Color fundus photograph; 2184 by 1690 pixels — 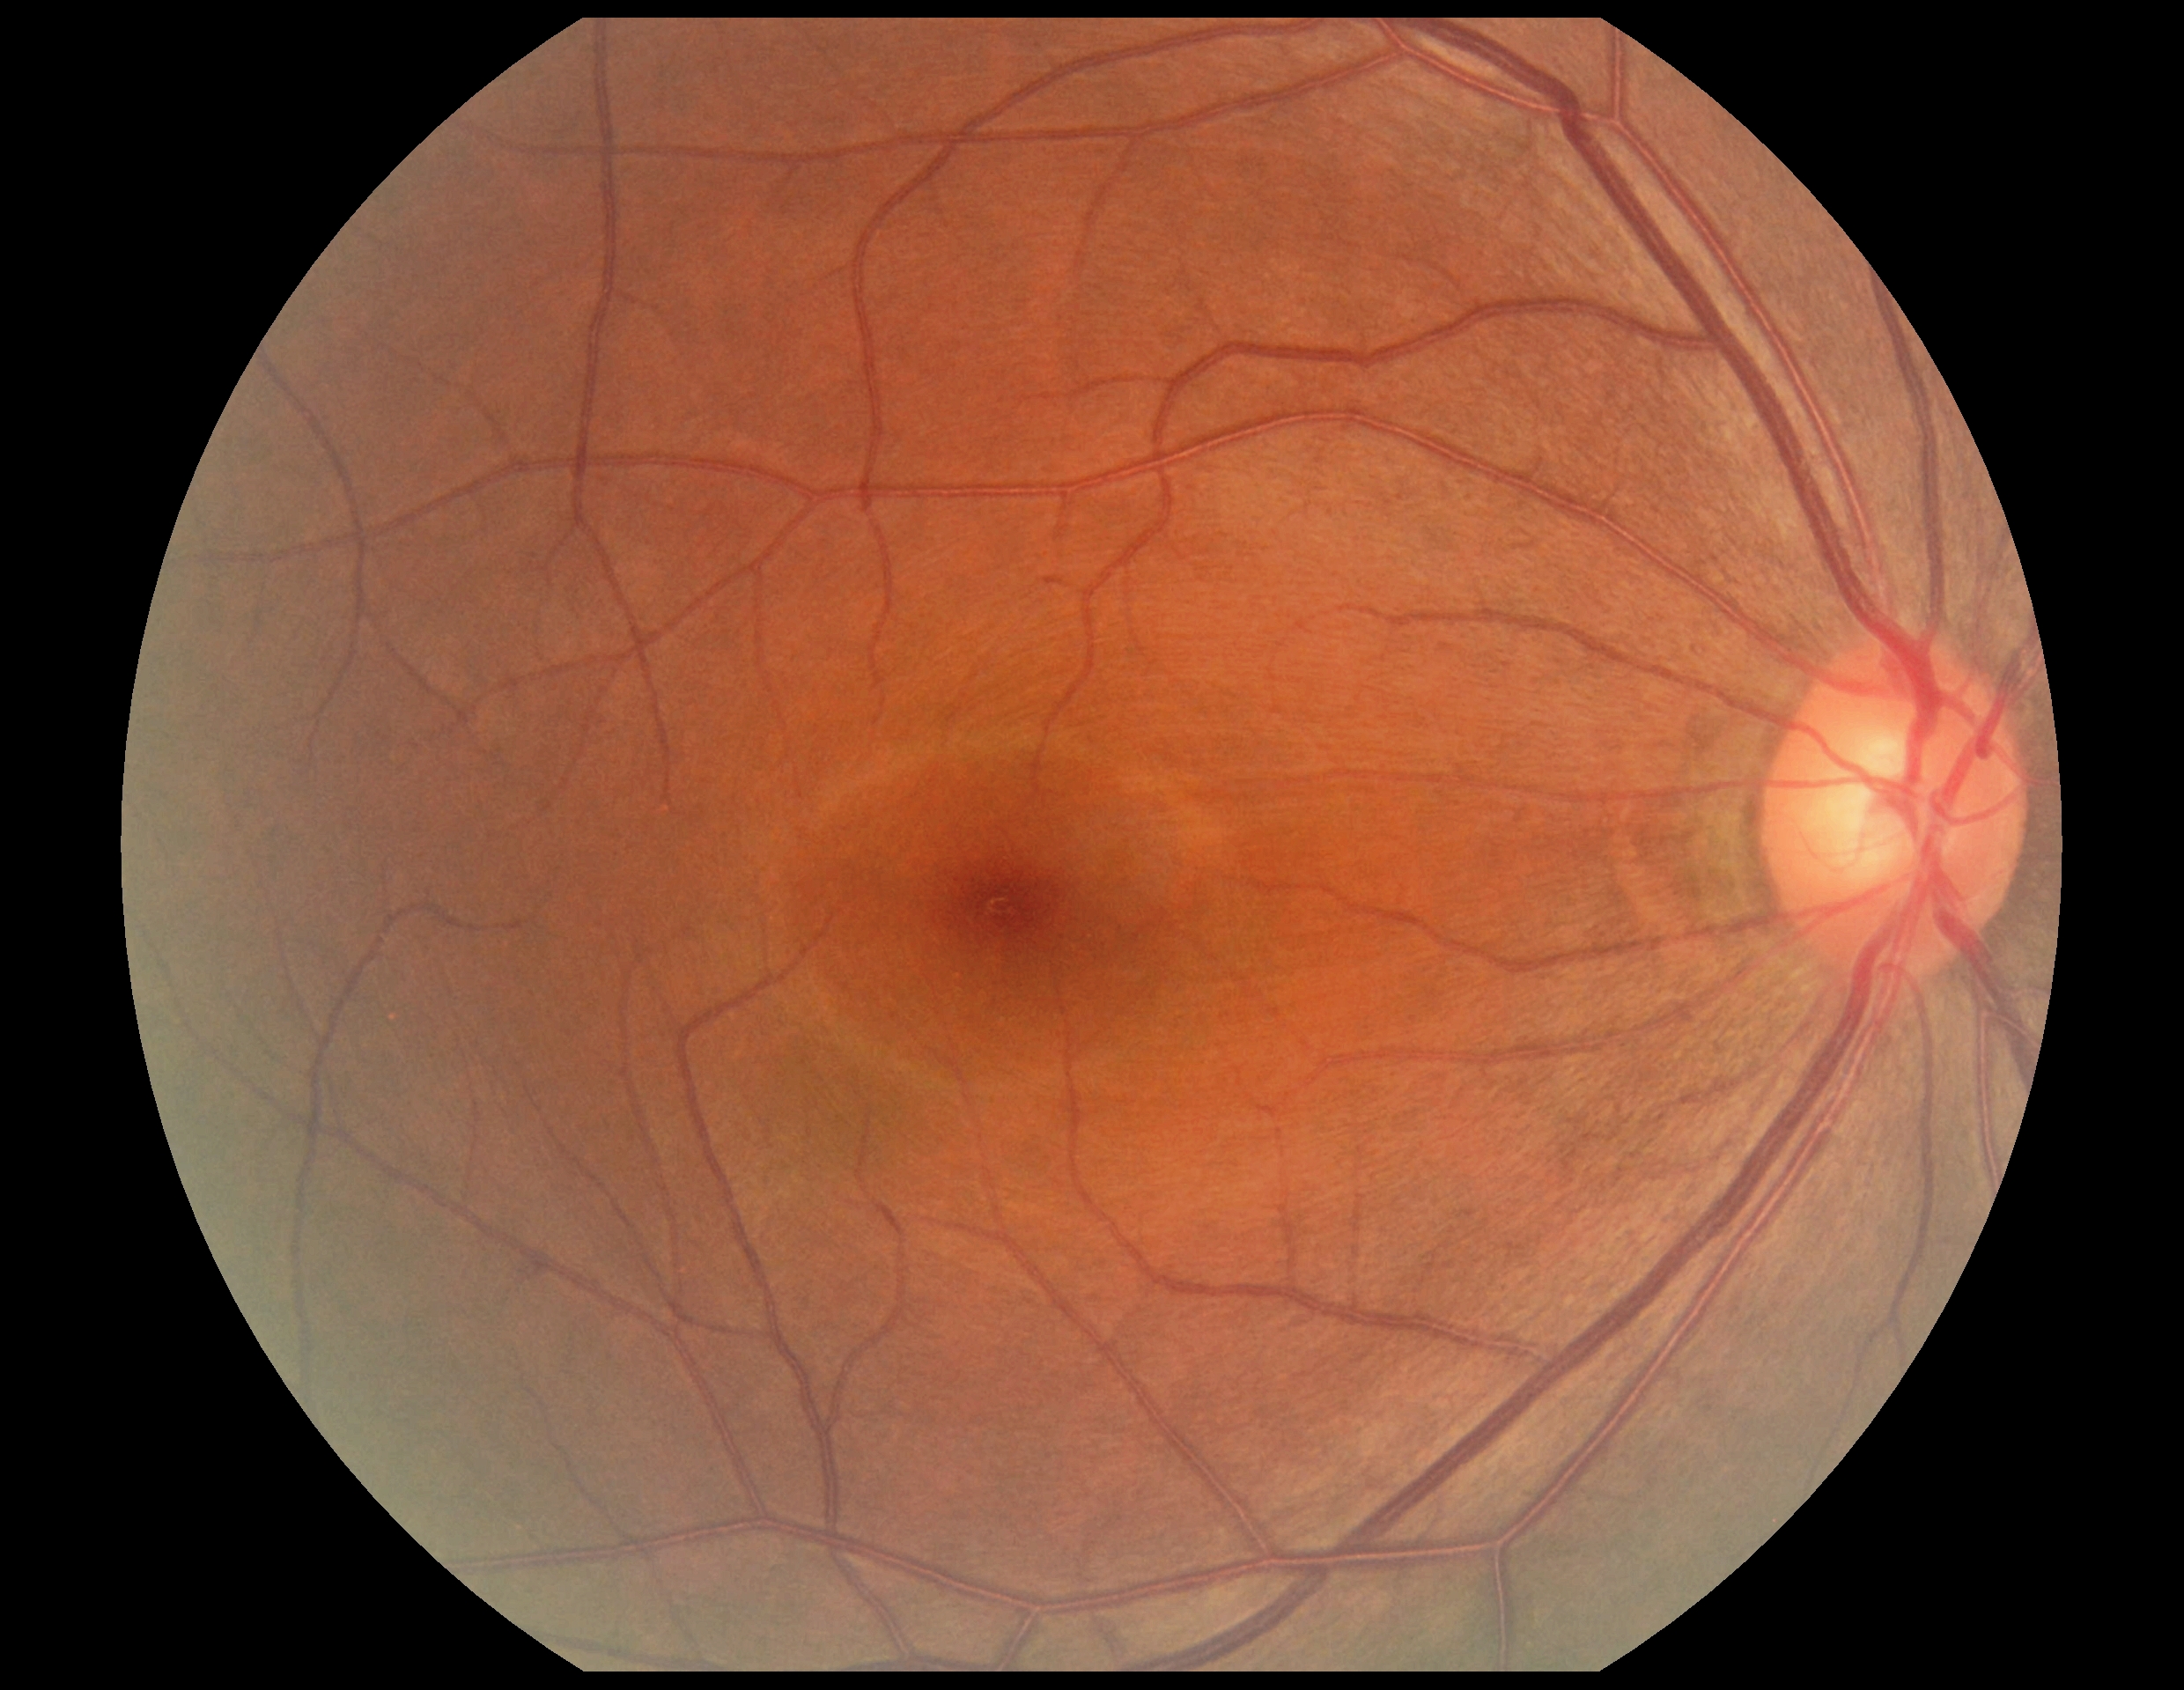
{"dr_grade": "grade 0"}